Phoenix ICON wide-field infant fundus image:
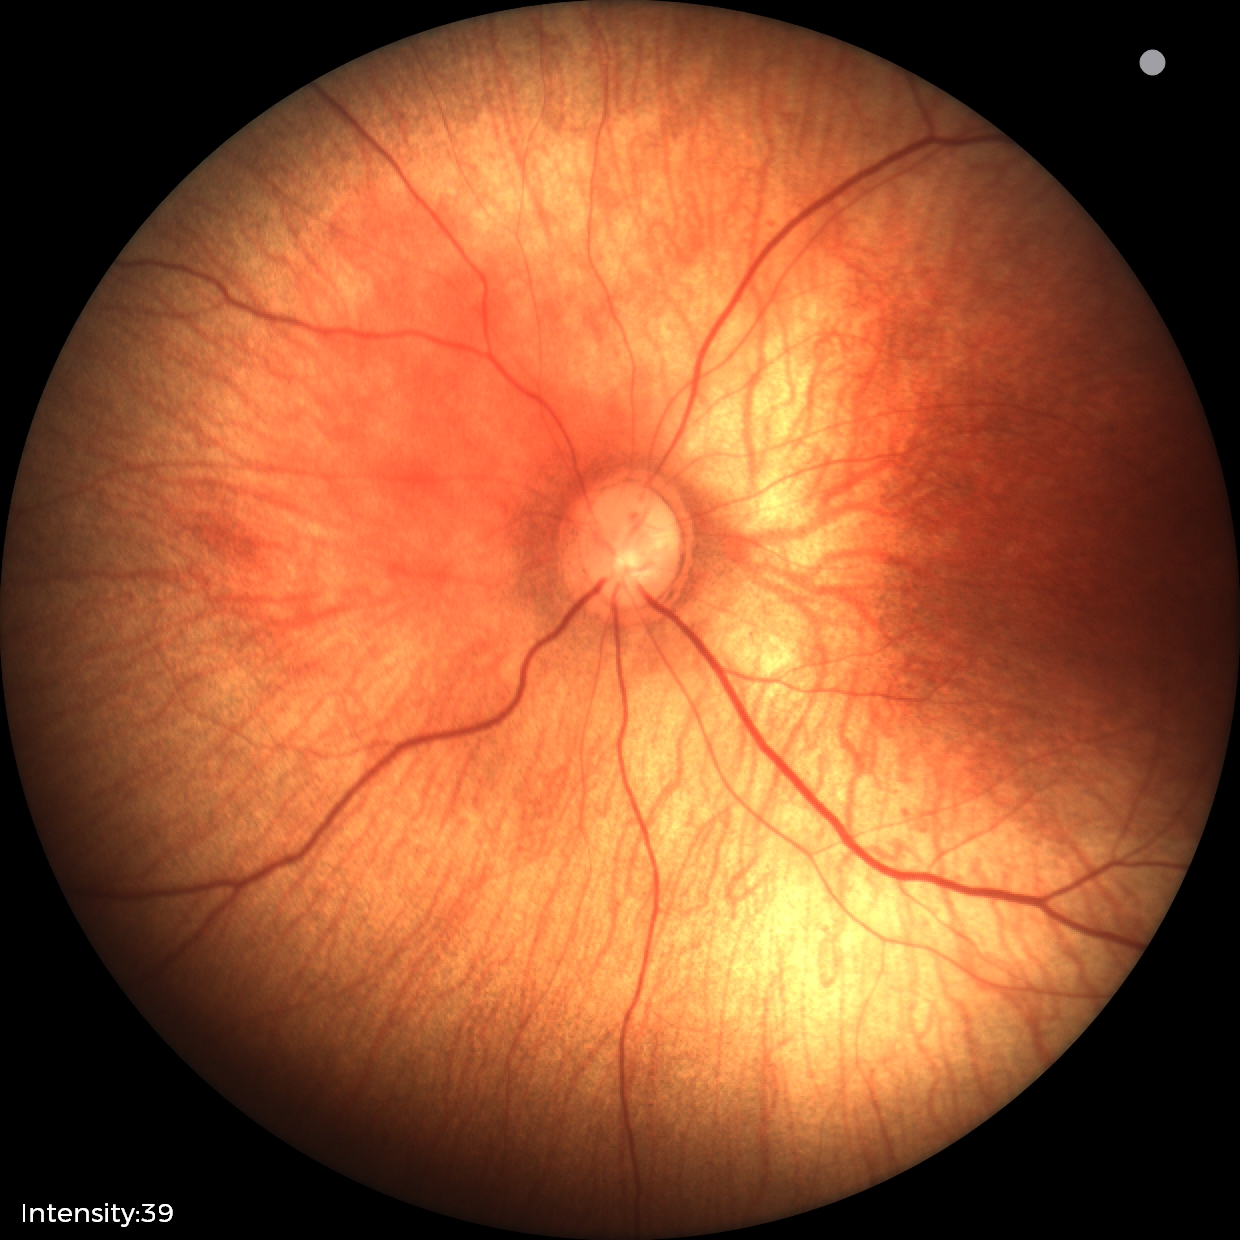

Assessment: no pathology identified